45 degree fundus photograph. CFP.
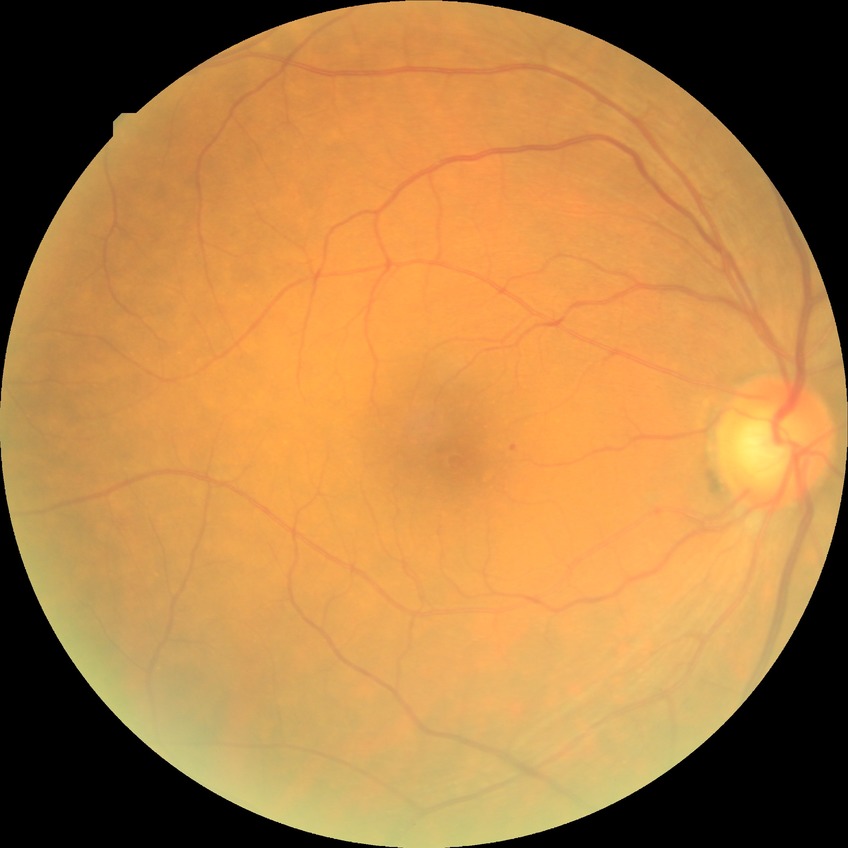 DR class: non-proliferative diabetic retinopathy; modified Davis grading: simple diabetic retinopathy.